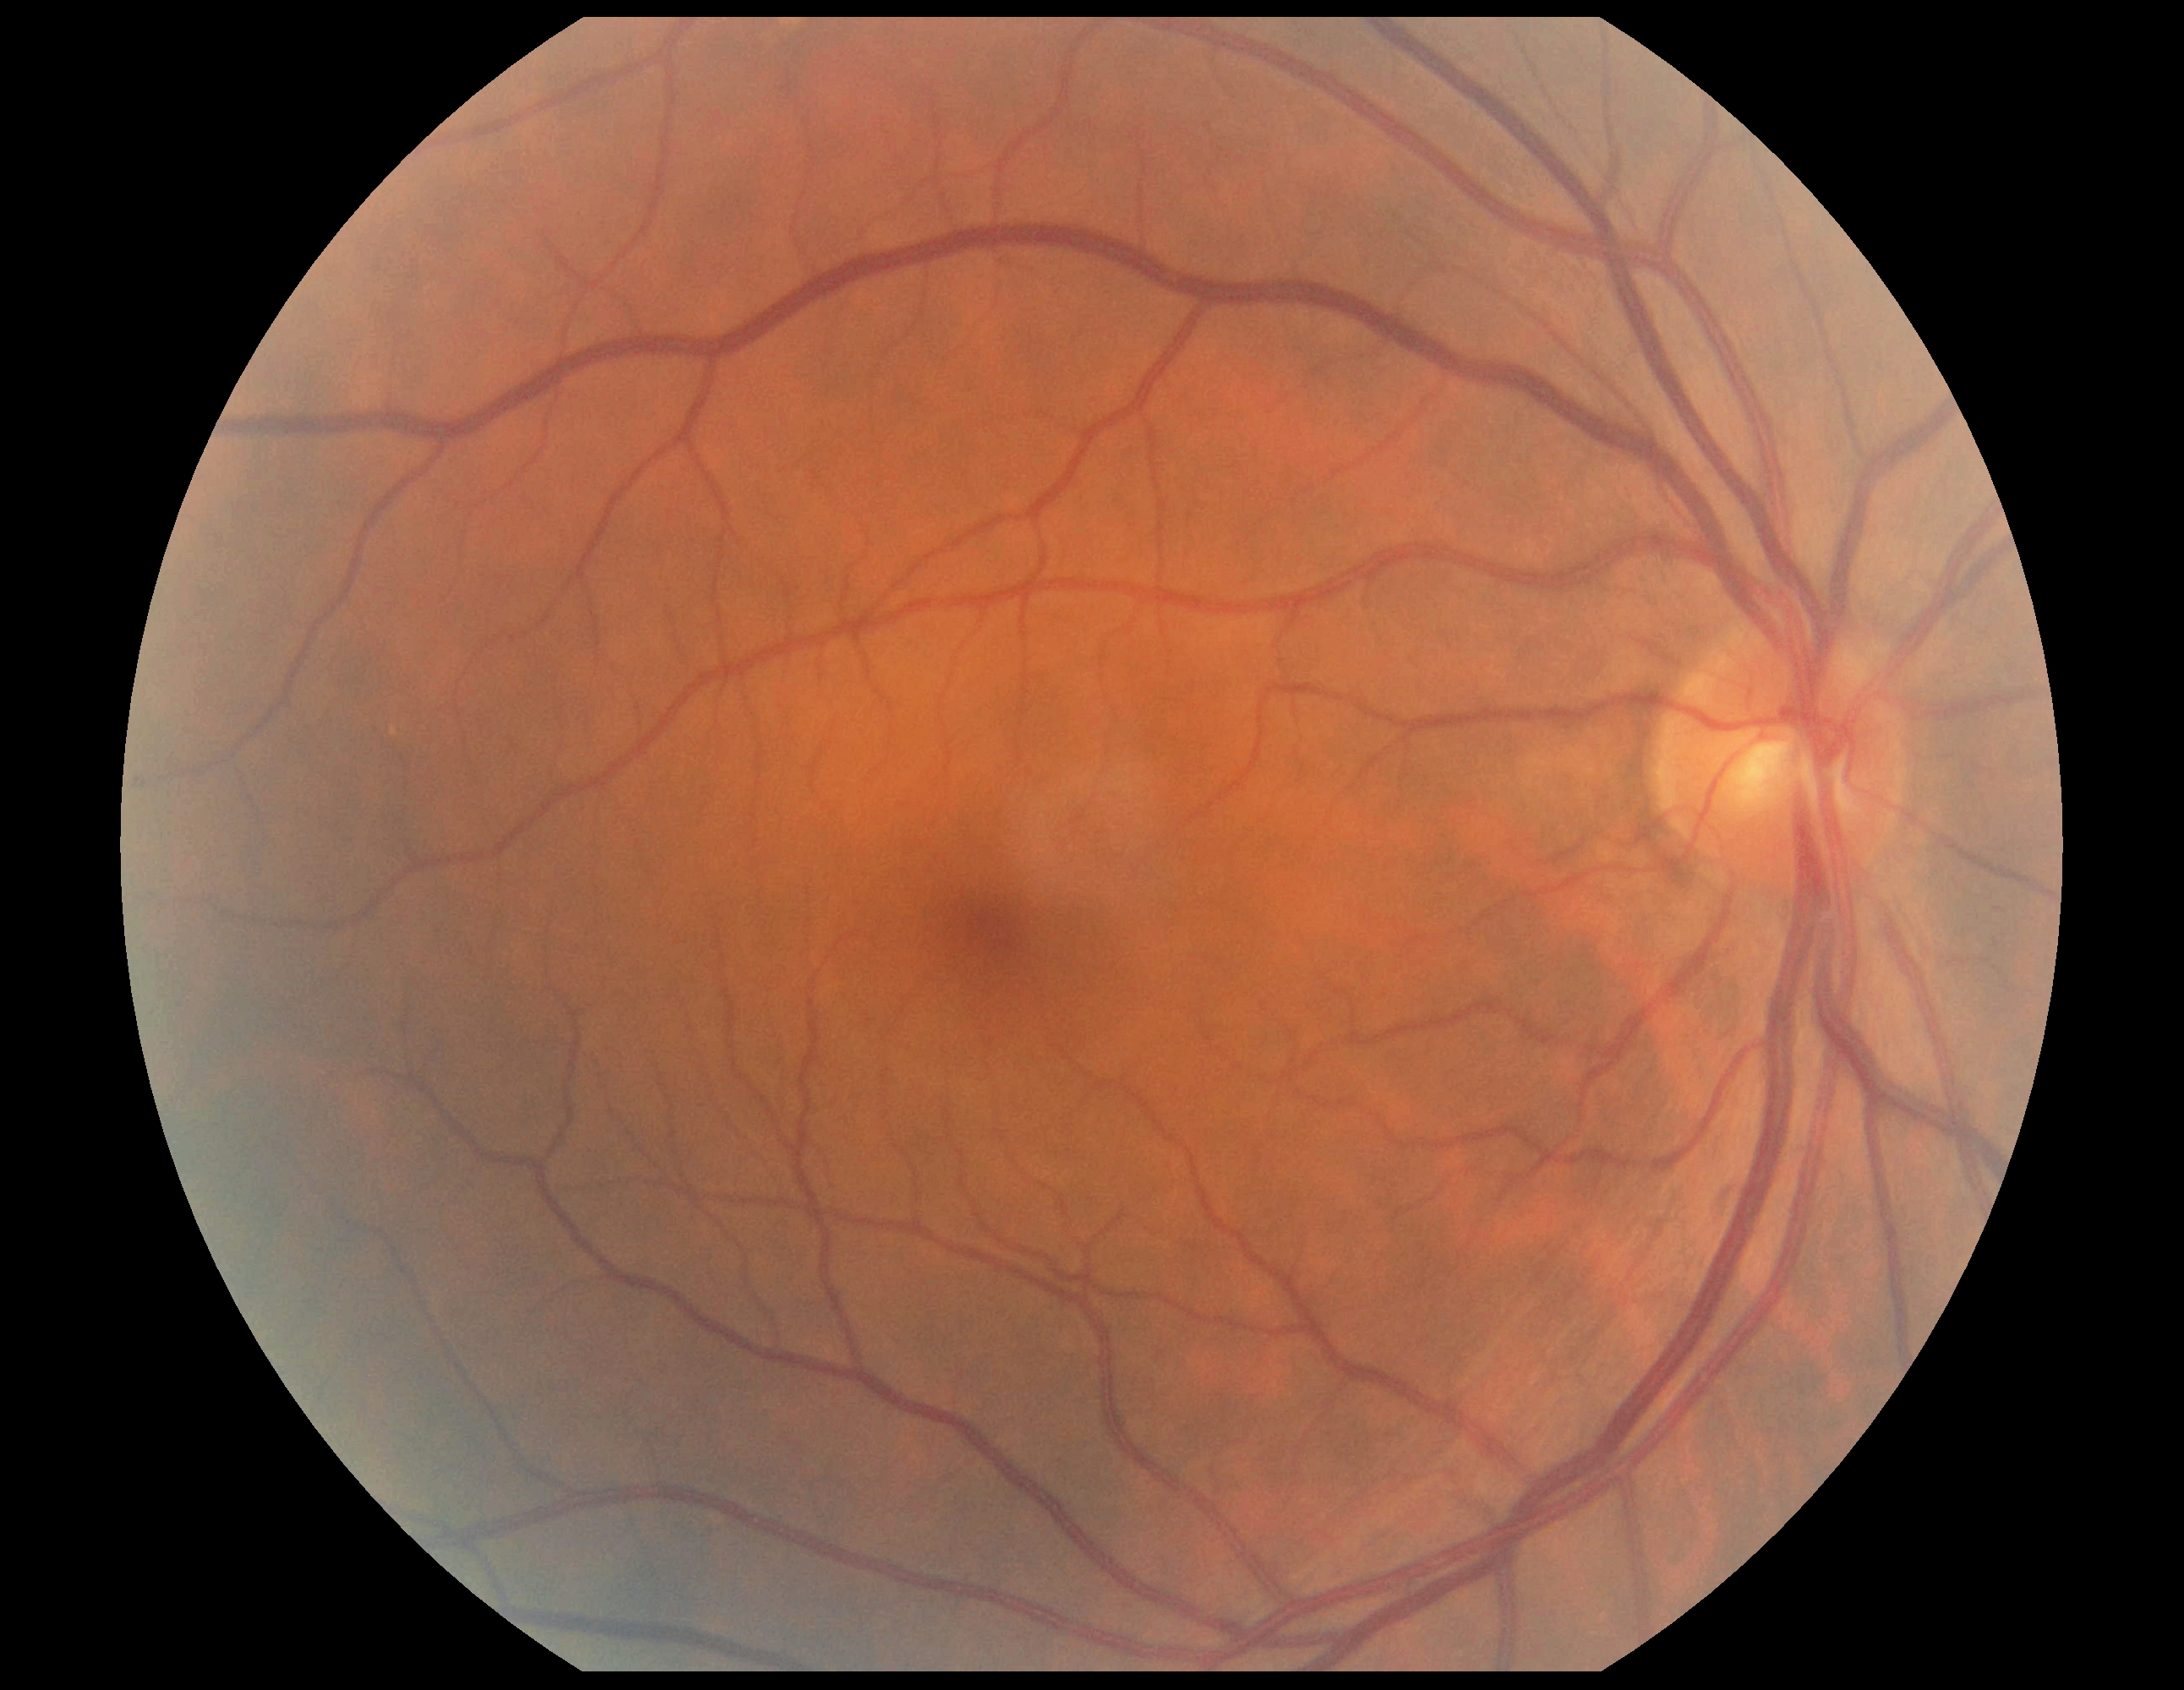
DR stage: grade 0 (no apparent retinopathy) — no visible signs of diabetic retinopathy.